Ultra-widefield fundus mosaic
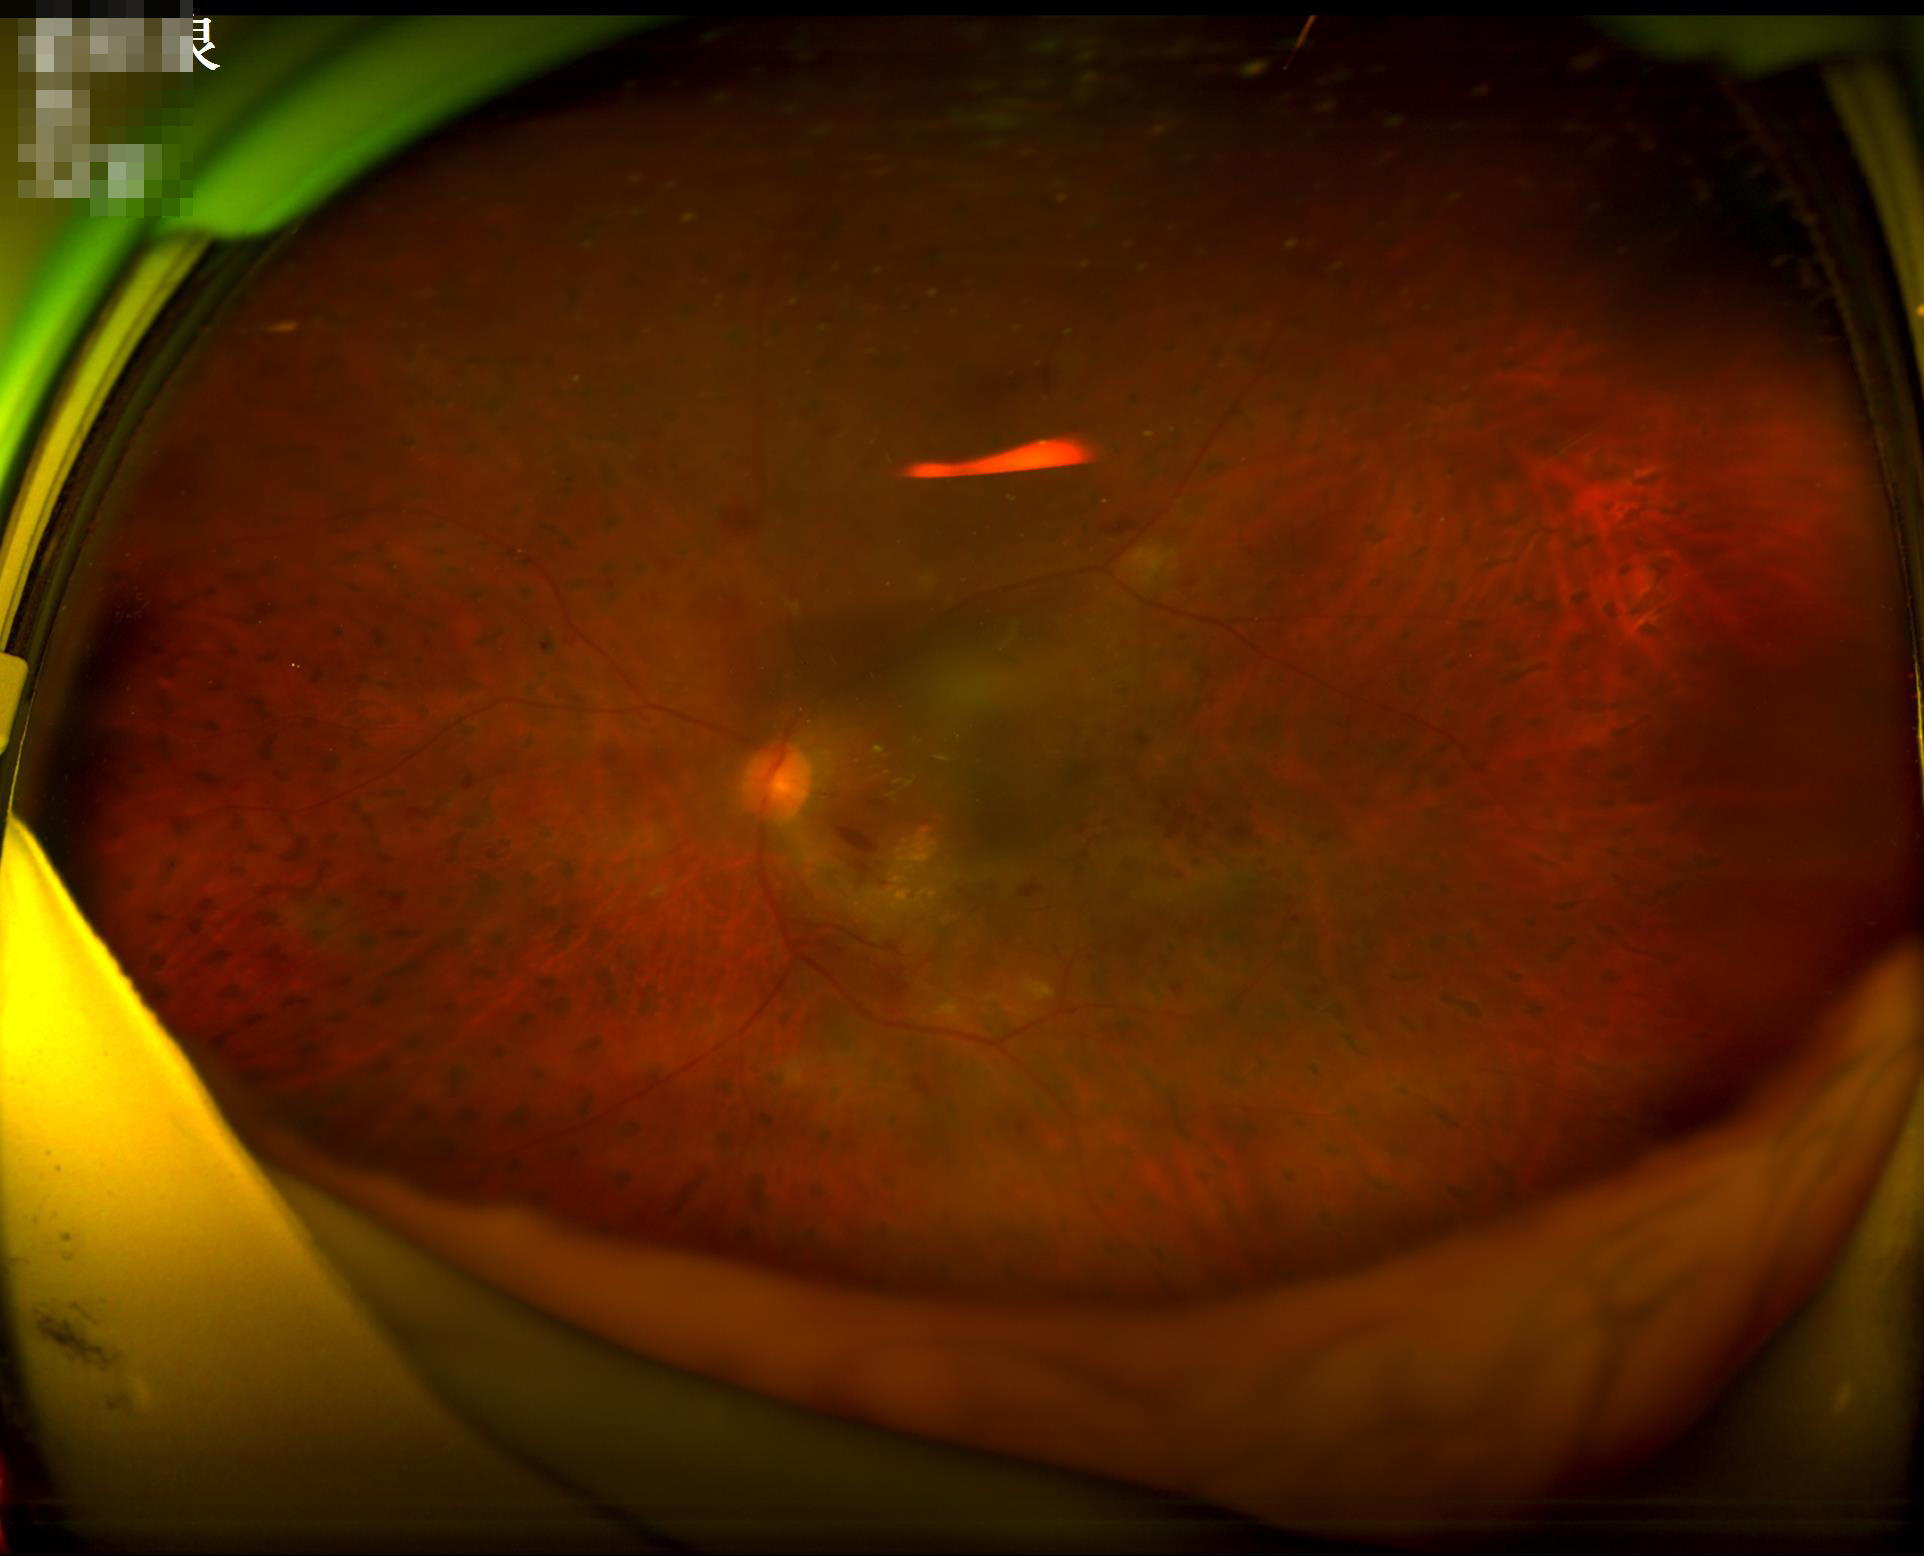 Image quality assessment: overall: inadequate for clinical interpretation; illumination/color: inadequate, with uneven exposure or color distortion; focus: noticeable blur in the optic disc, vessels, or background; contrast: low, vessels and details hard to distinguish.